Modified Davis grading.
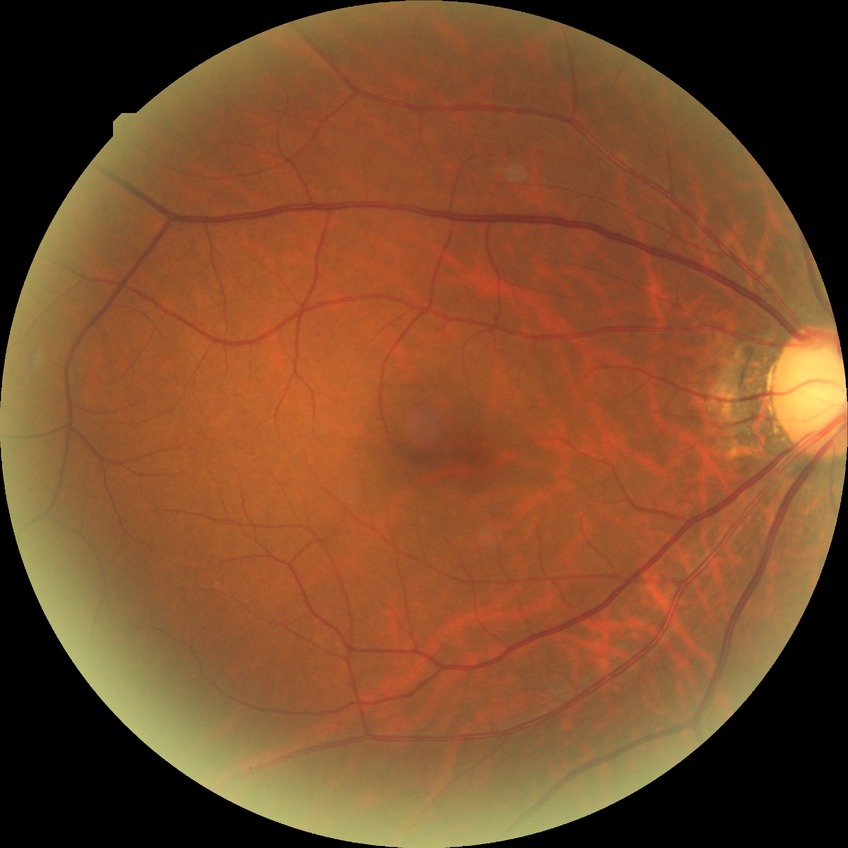
DR grade: NDR